Color fundus photograph. FOV: 45 degrees. 2352x1568
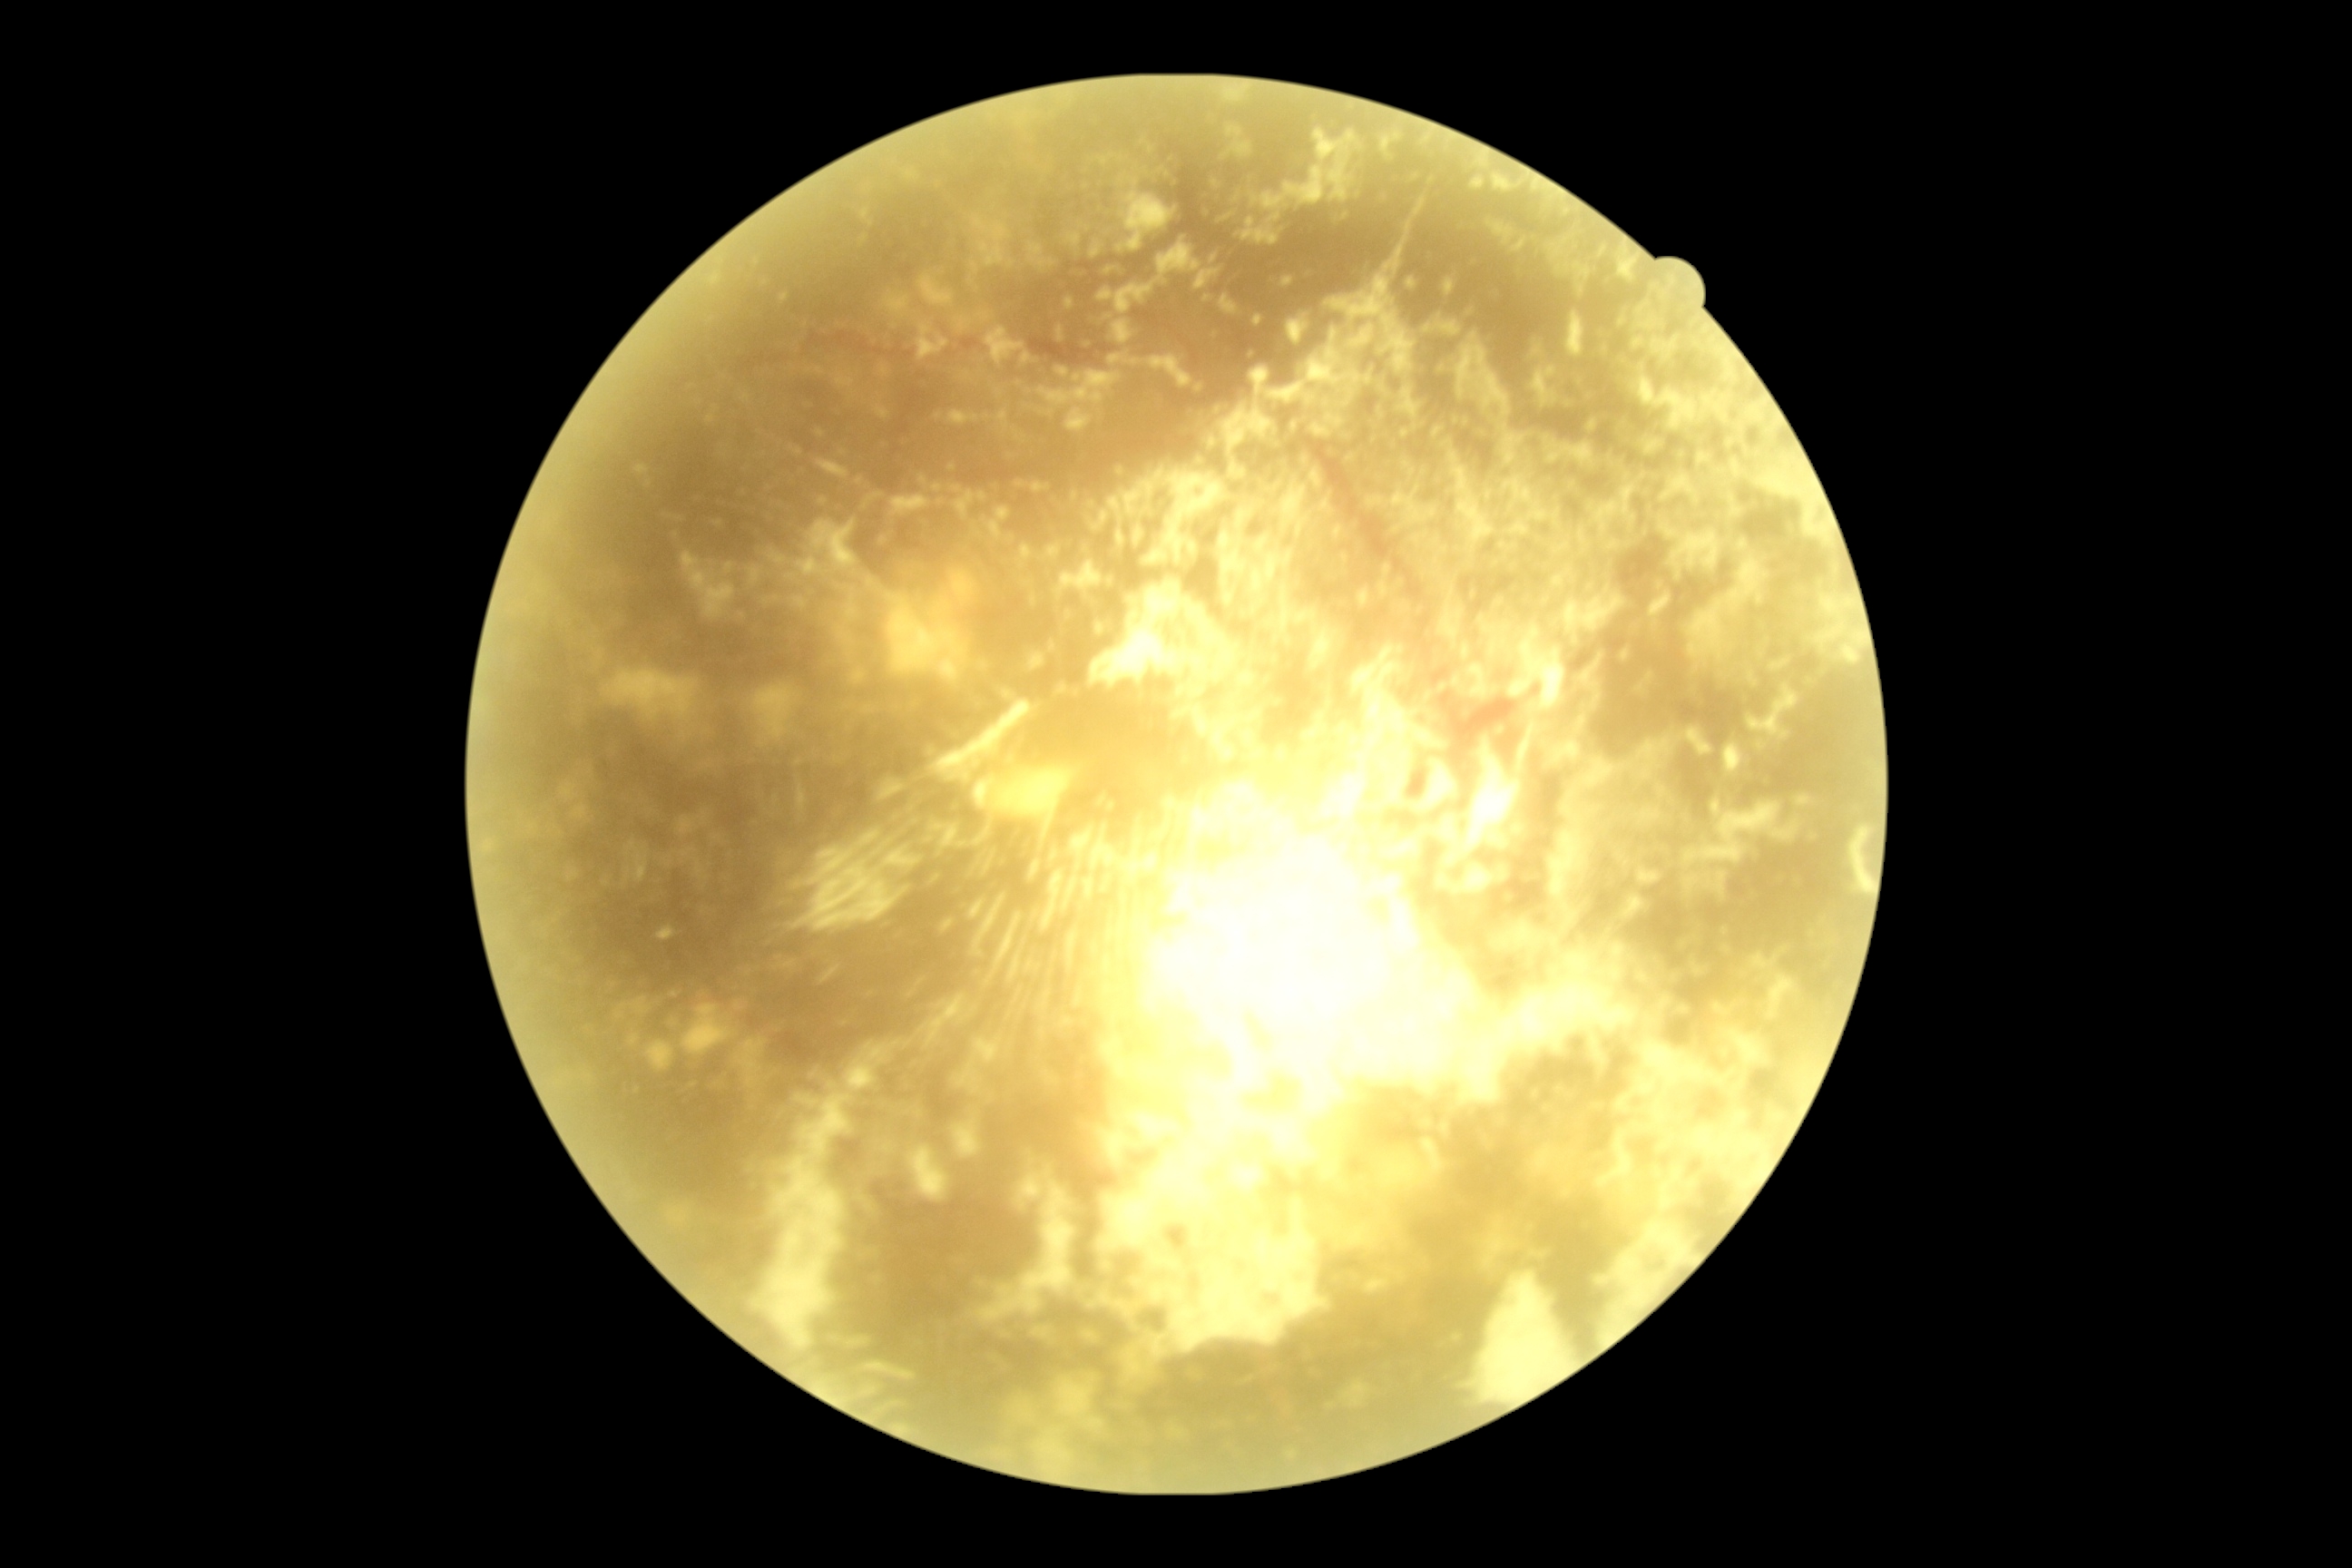
Findings:
- DR grade: ungradable